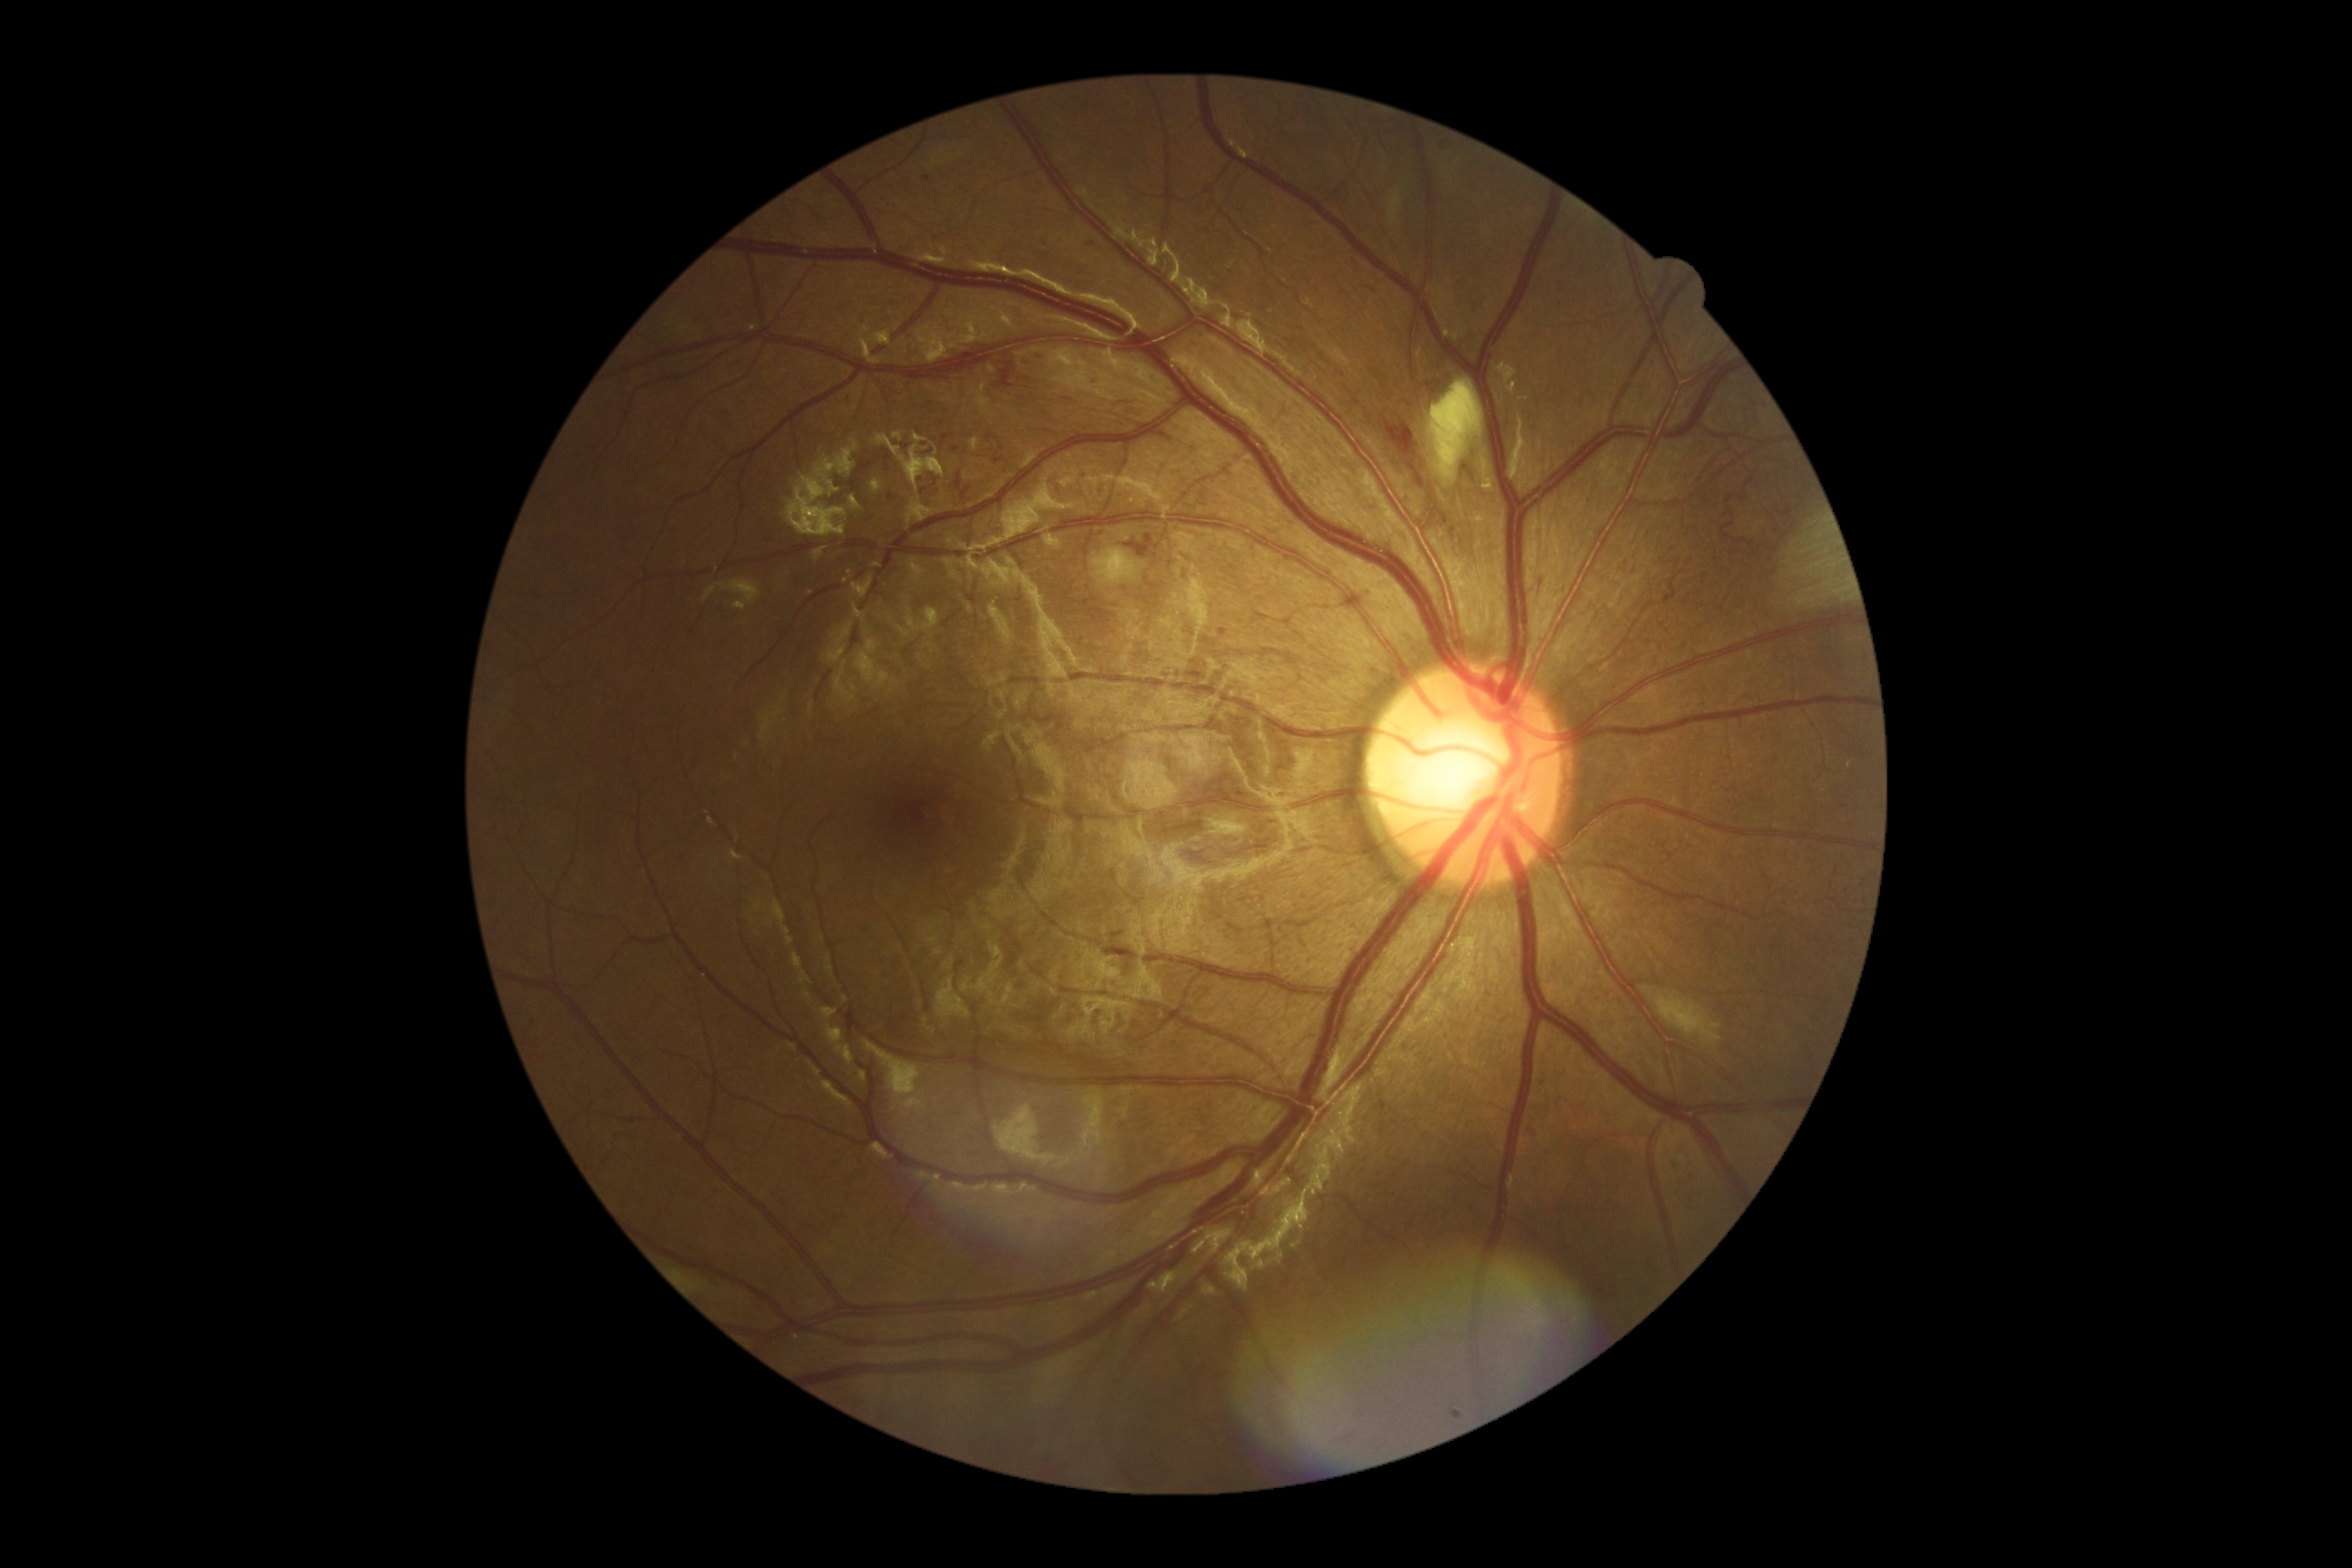

DR grade is moderate NPDR (2).